Mydriatic (tropicamide 0.5%); 50° FOV; color fundus photograph; centered on the macula: 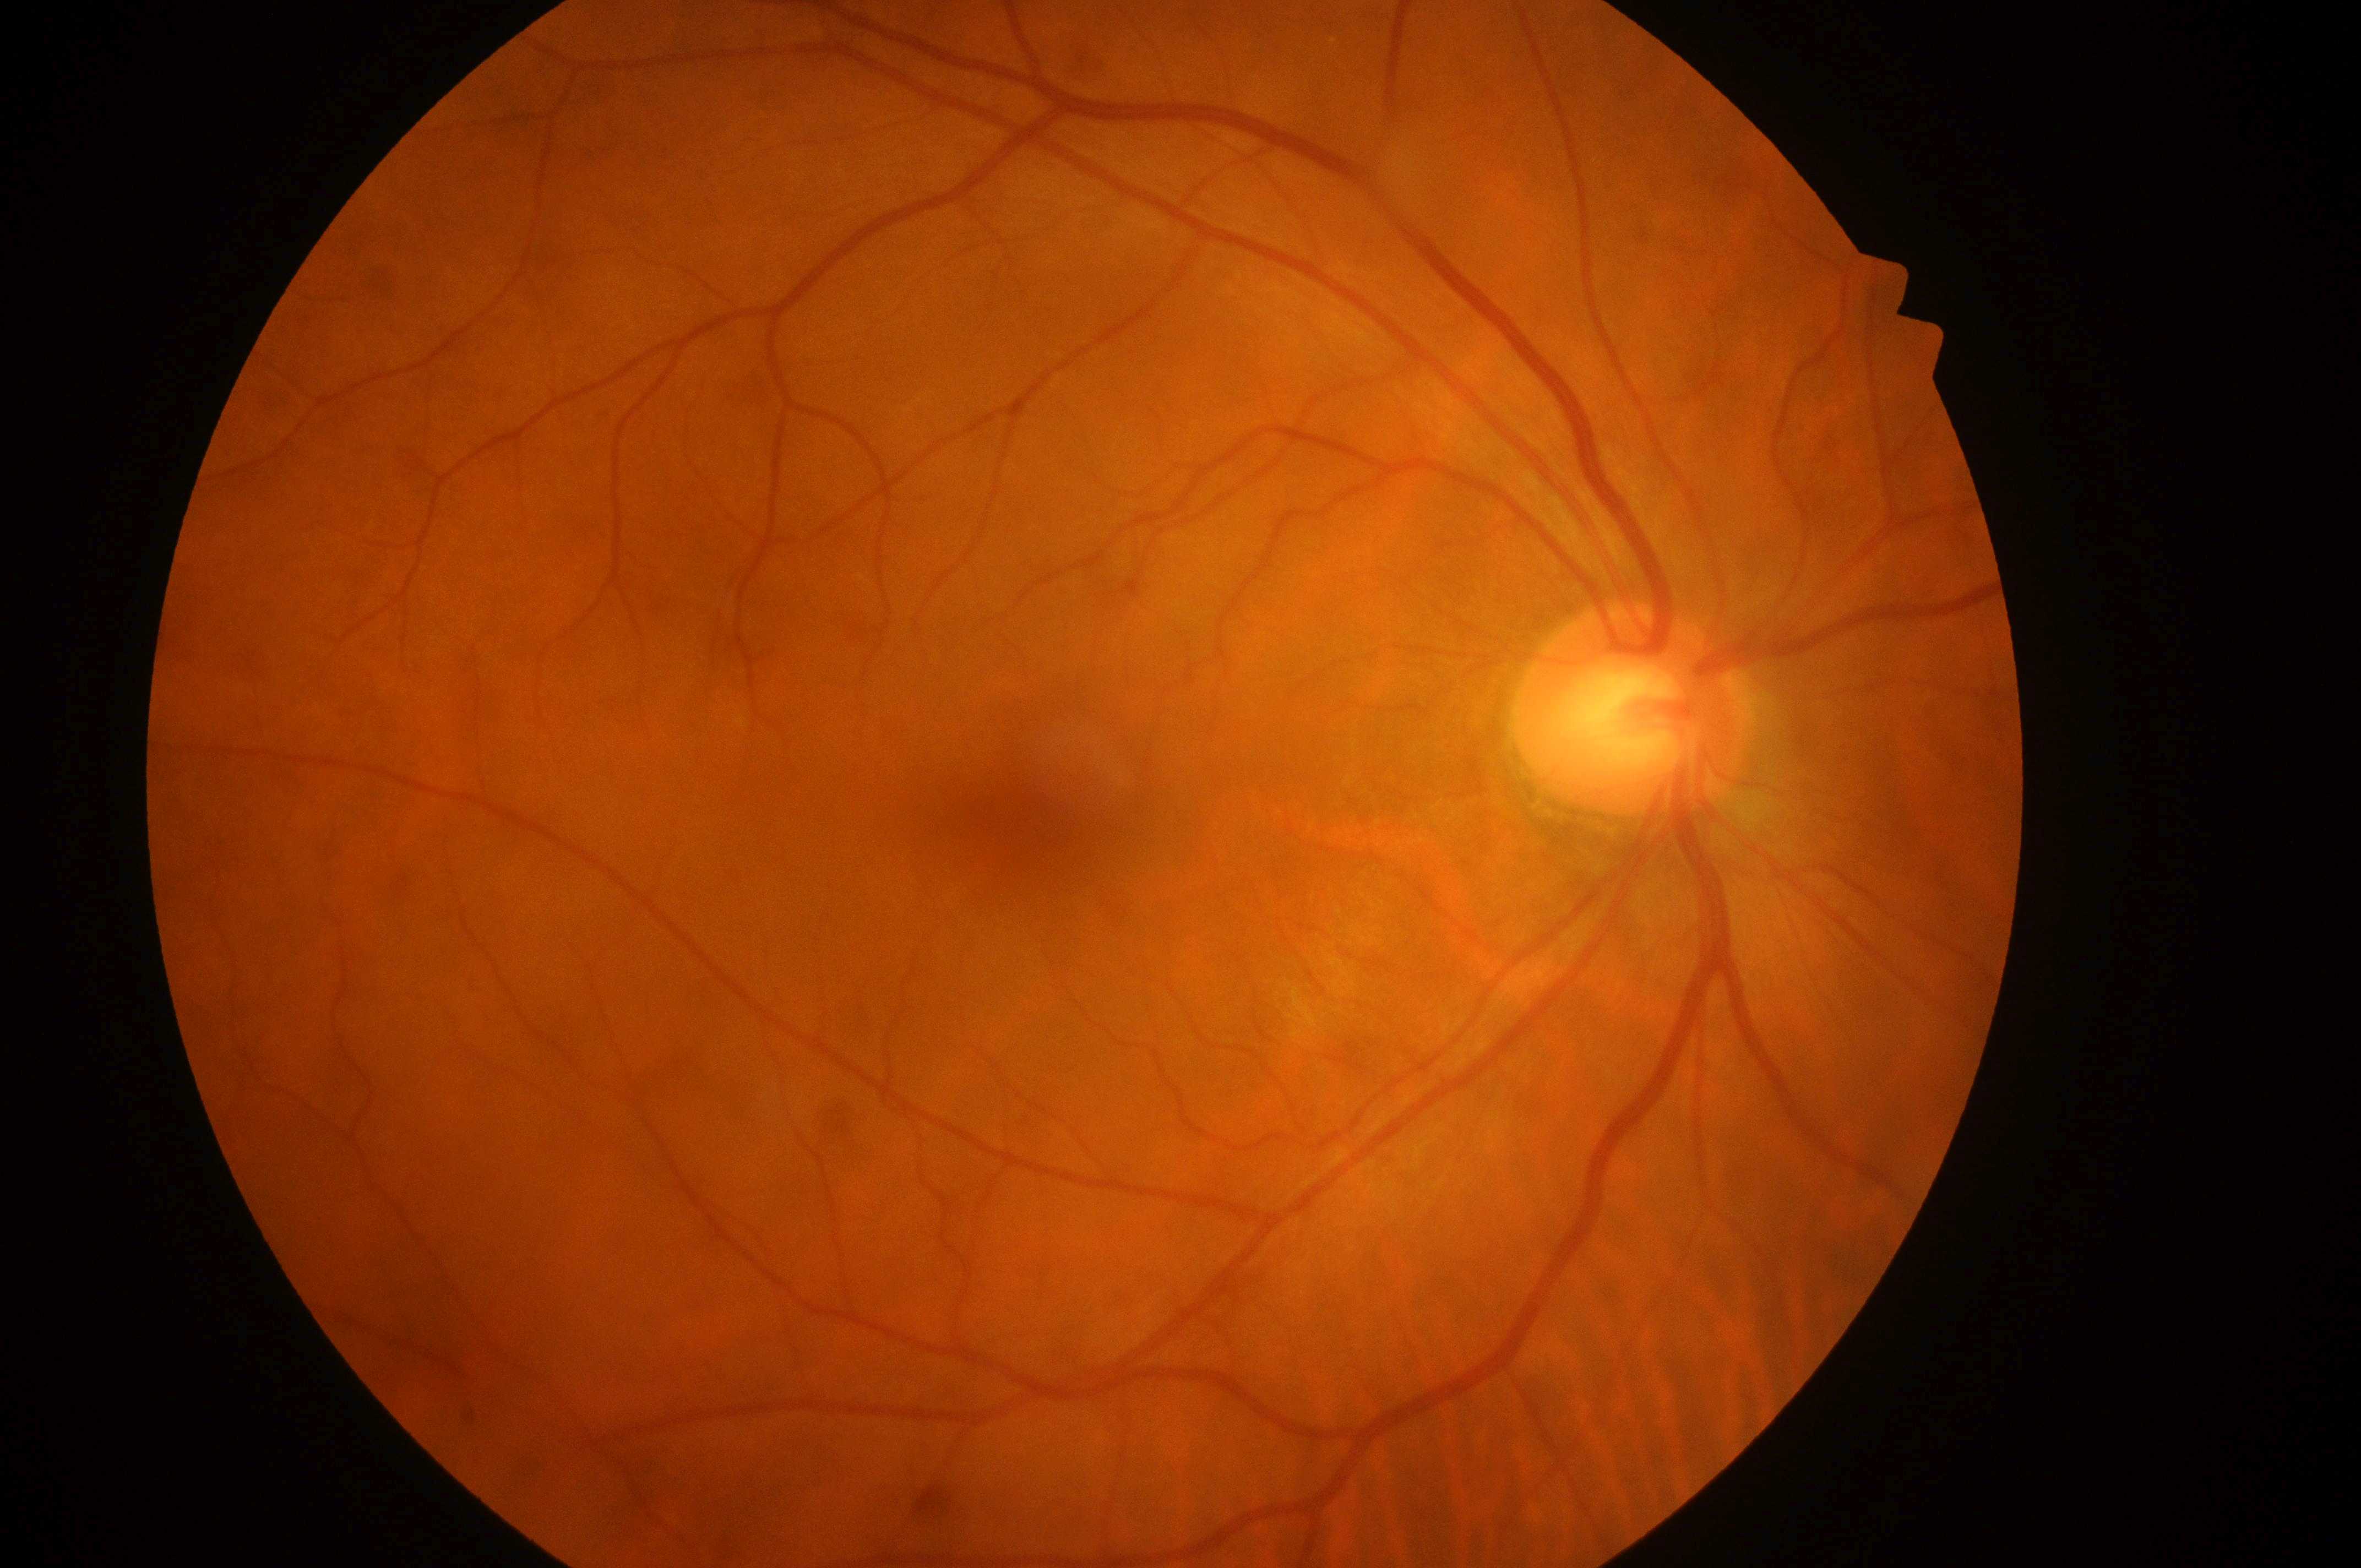

| field | value |
|---|---|
| DR impression | No diabetic retinal disease findings |
| optic disc center | 1630px, 719px |
| diabetic retinopathy severity | no apparent retinopathy (grade 0) |
| laterality | right eye |
| fovea centralis | 1015px, 829px |
| risk of diabetic macular edema | grade 0 (no risk) |